Acquired on the Natus RetCam Envision; pediatric retinal photograph (wide-field): 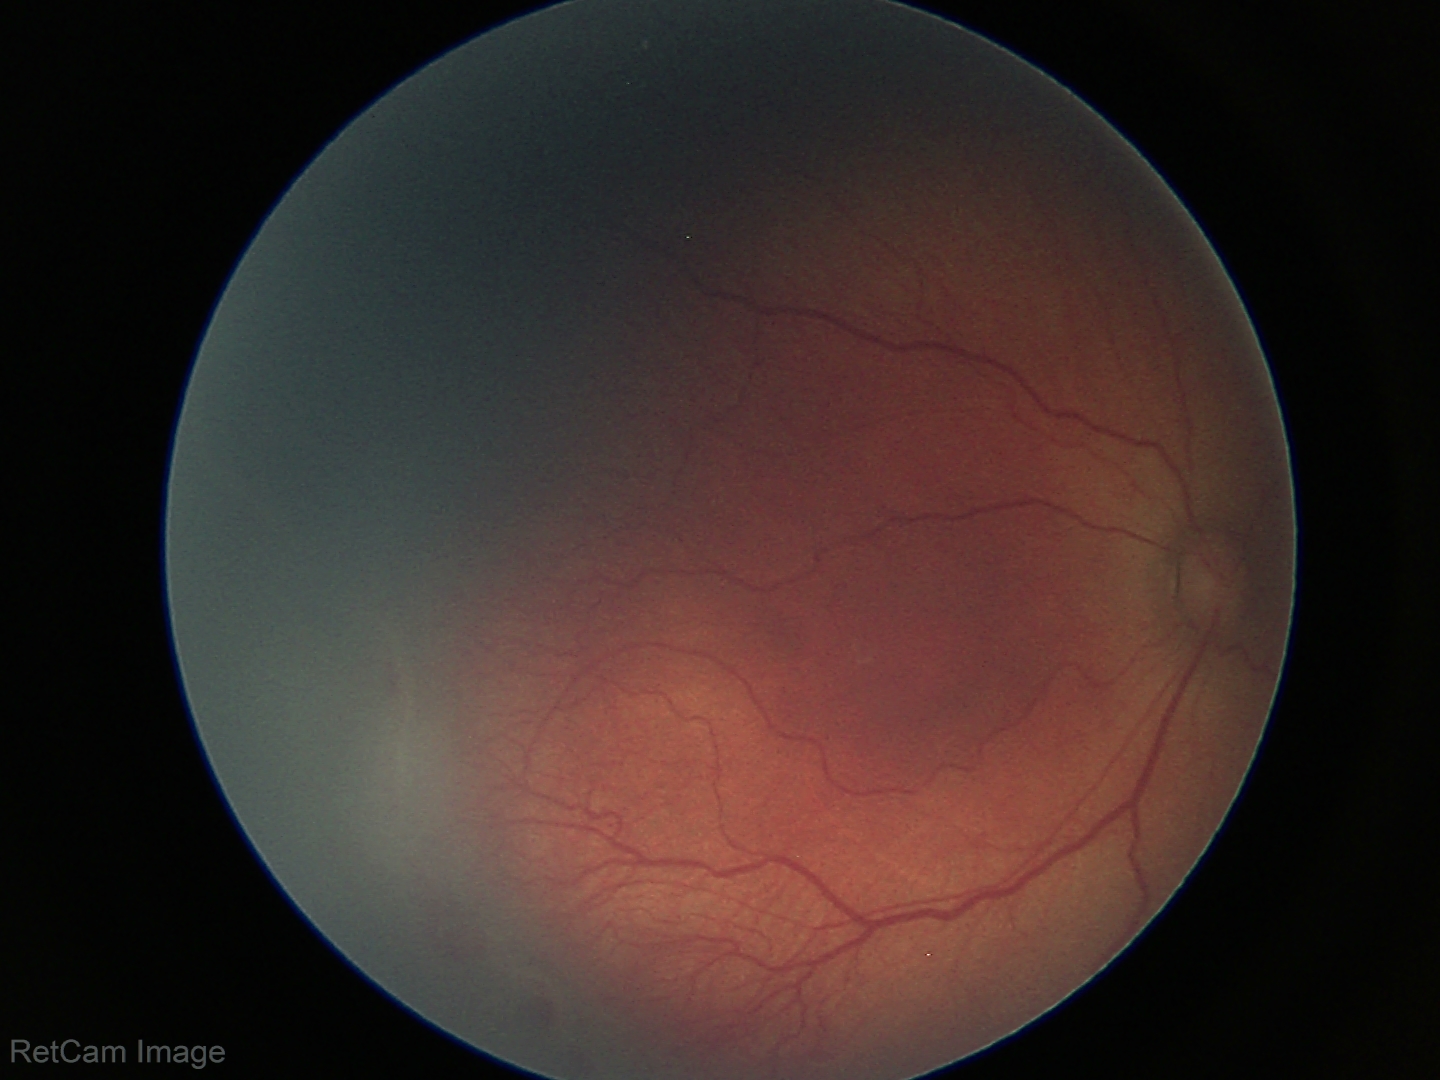

Screening examination consistent with ROP stage 2.
Without plus disease.